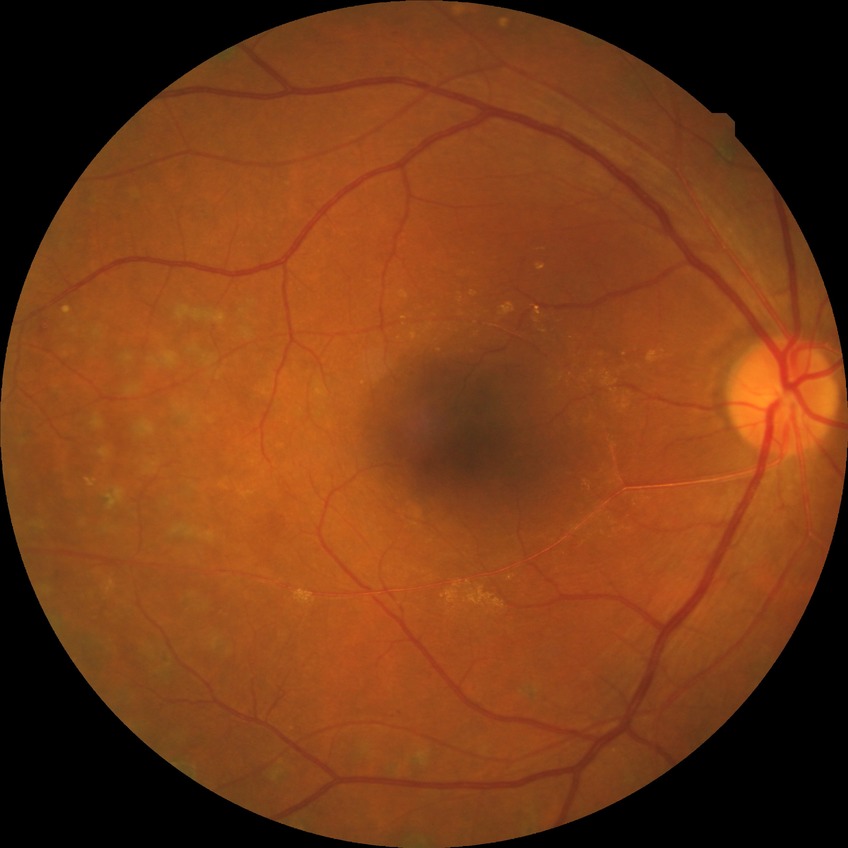
Diabetic retinopathy (DR) is PDR (proliferative diabetic retinopathy).